Camera: Phoenix ICON (100° FOV); wide-field fundus photograph from neonatal ROP screening; 1240 by 1240 pixels.
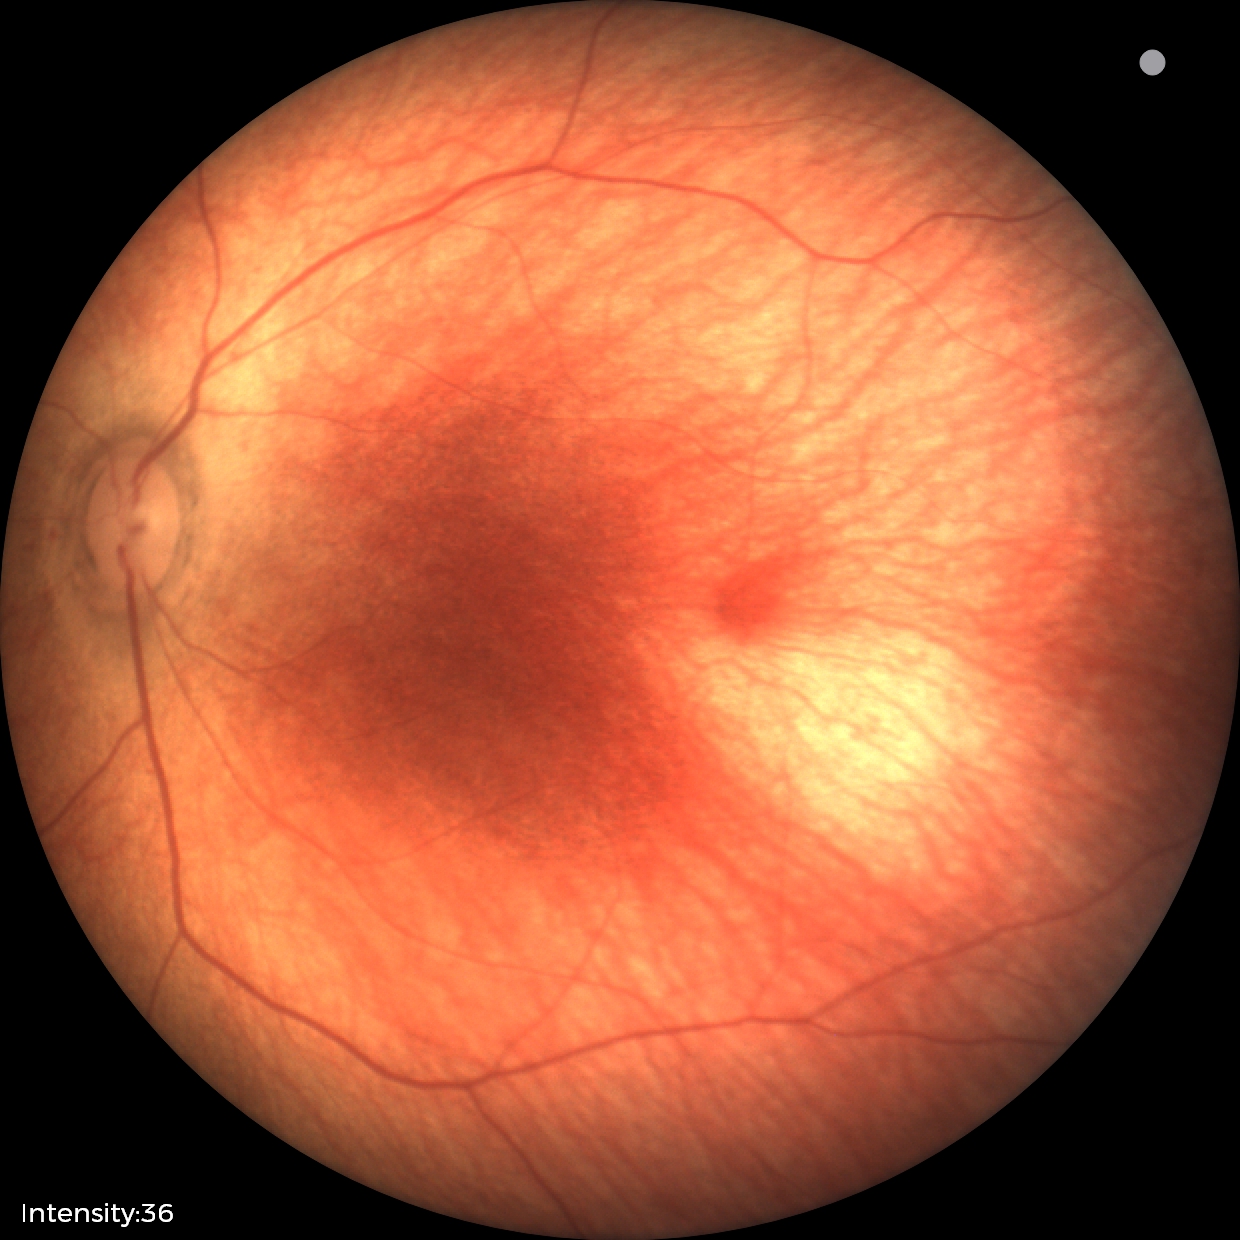

Impression: physiological finding.